45-degree field of view
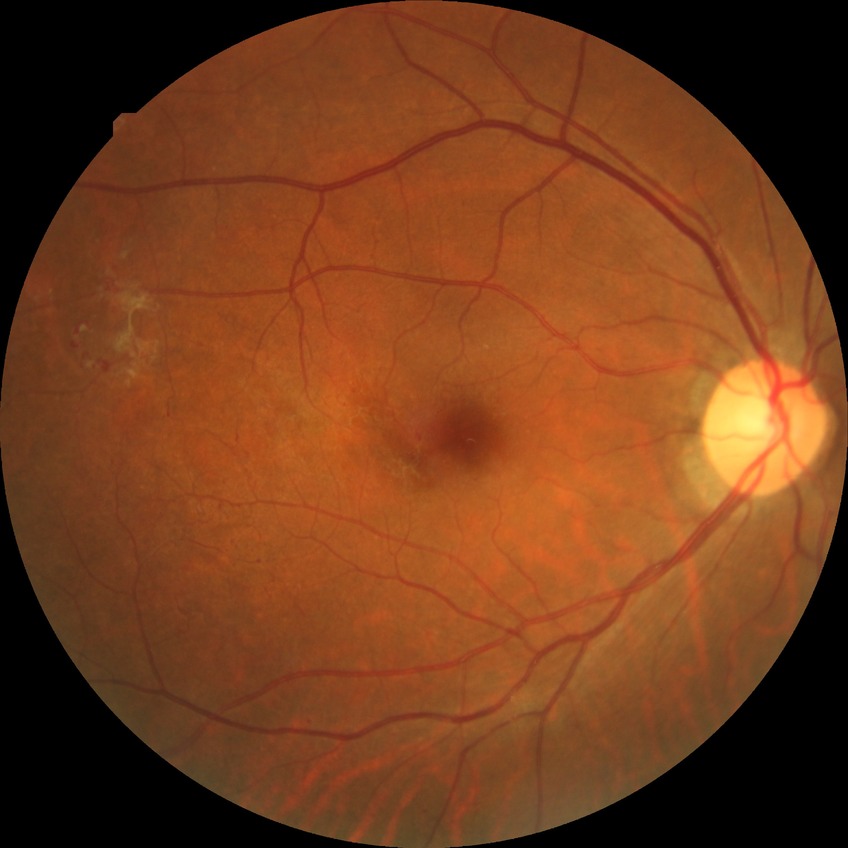 Diabetic retinopathy stage: proliferative diabetic retinopathy.